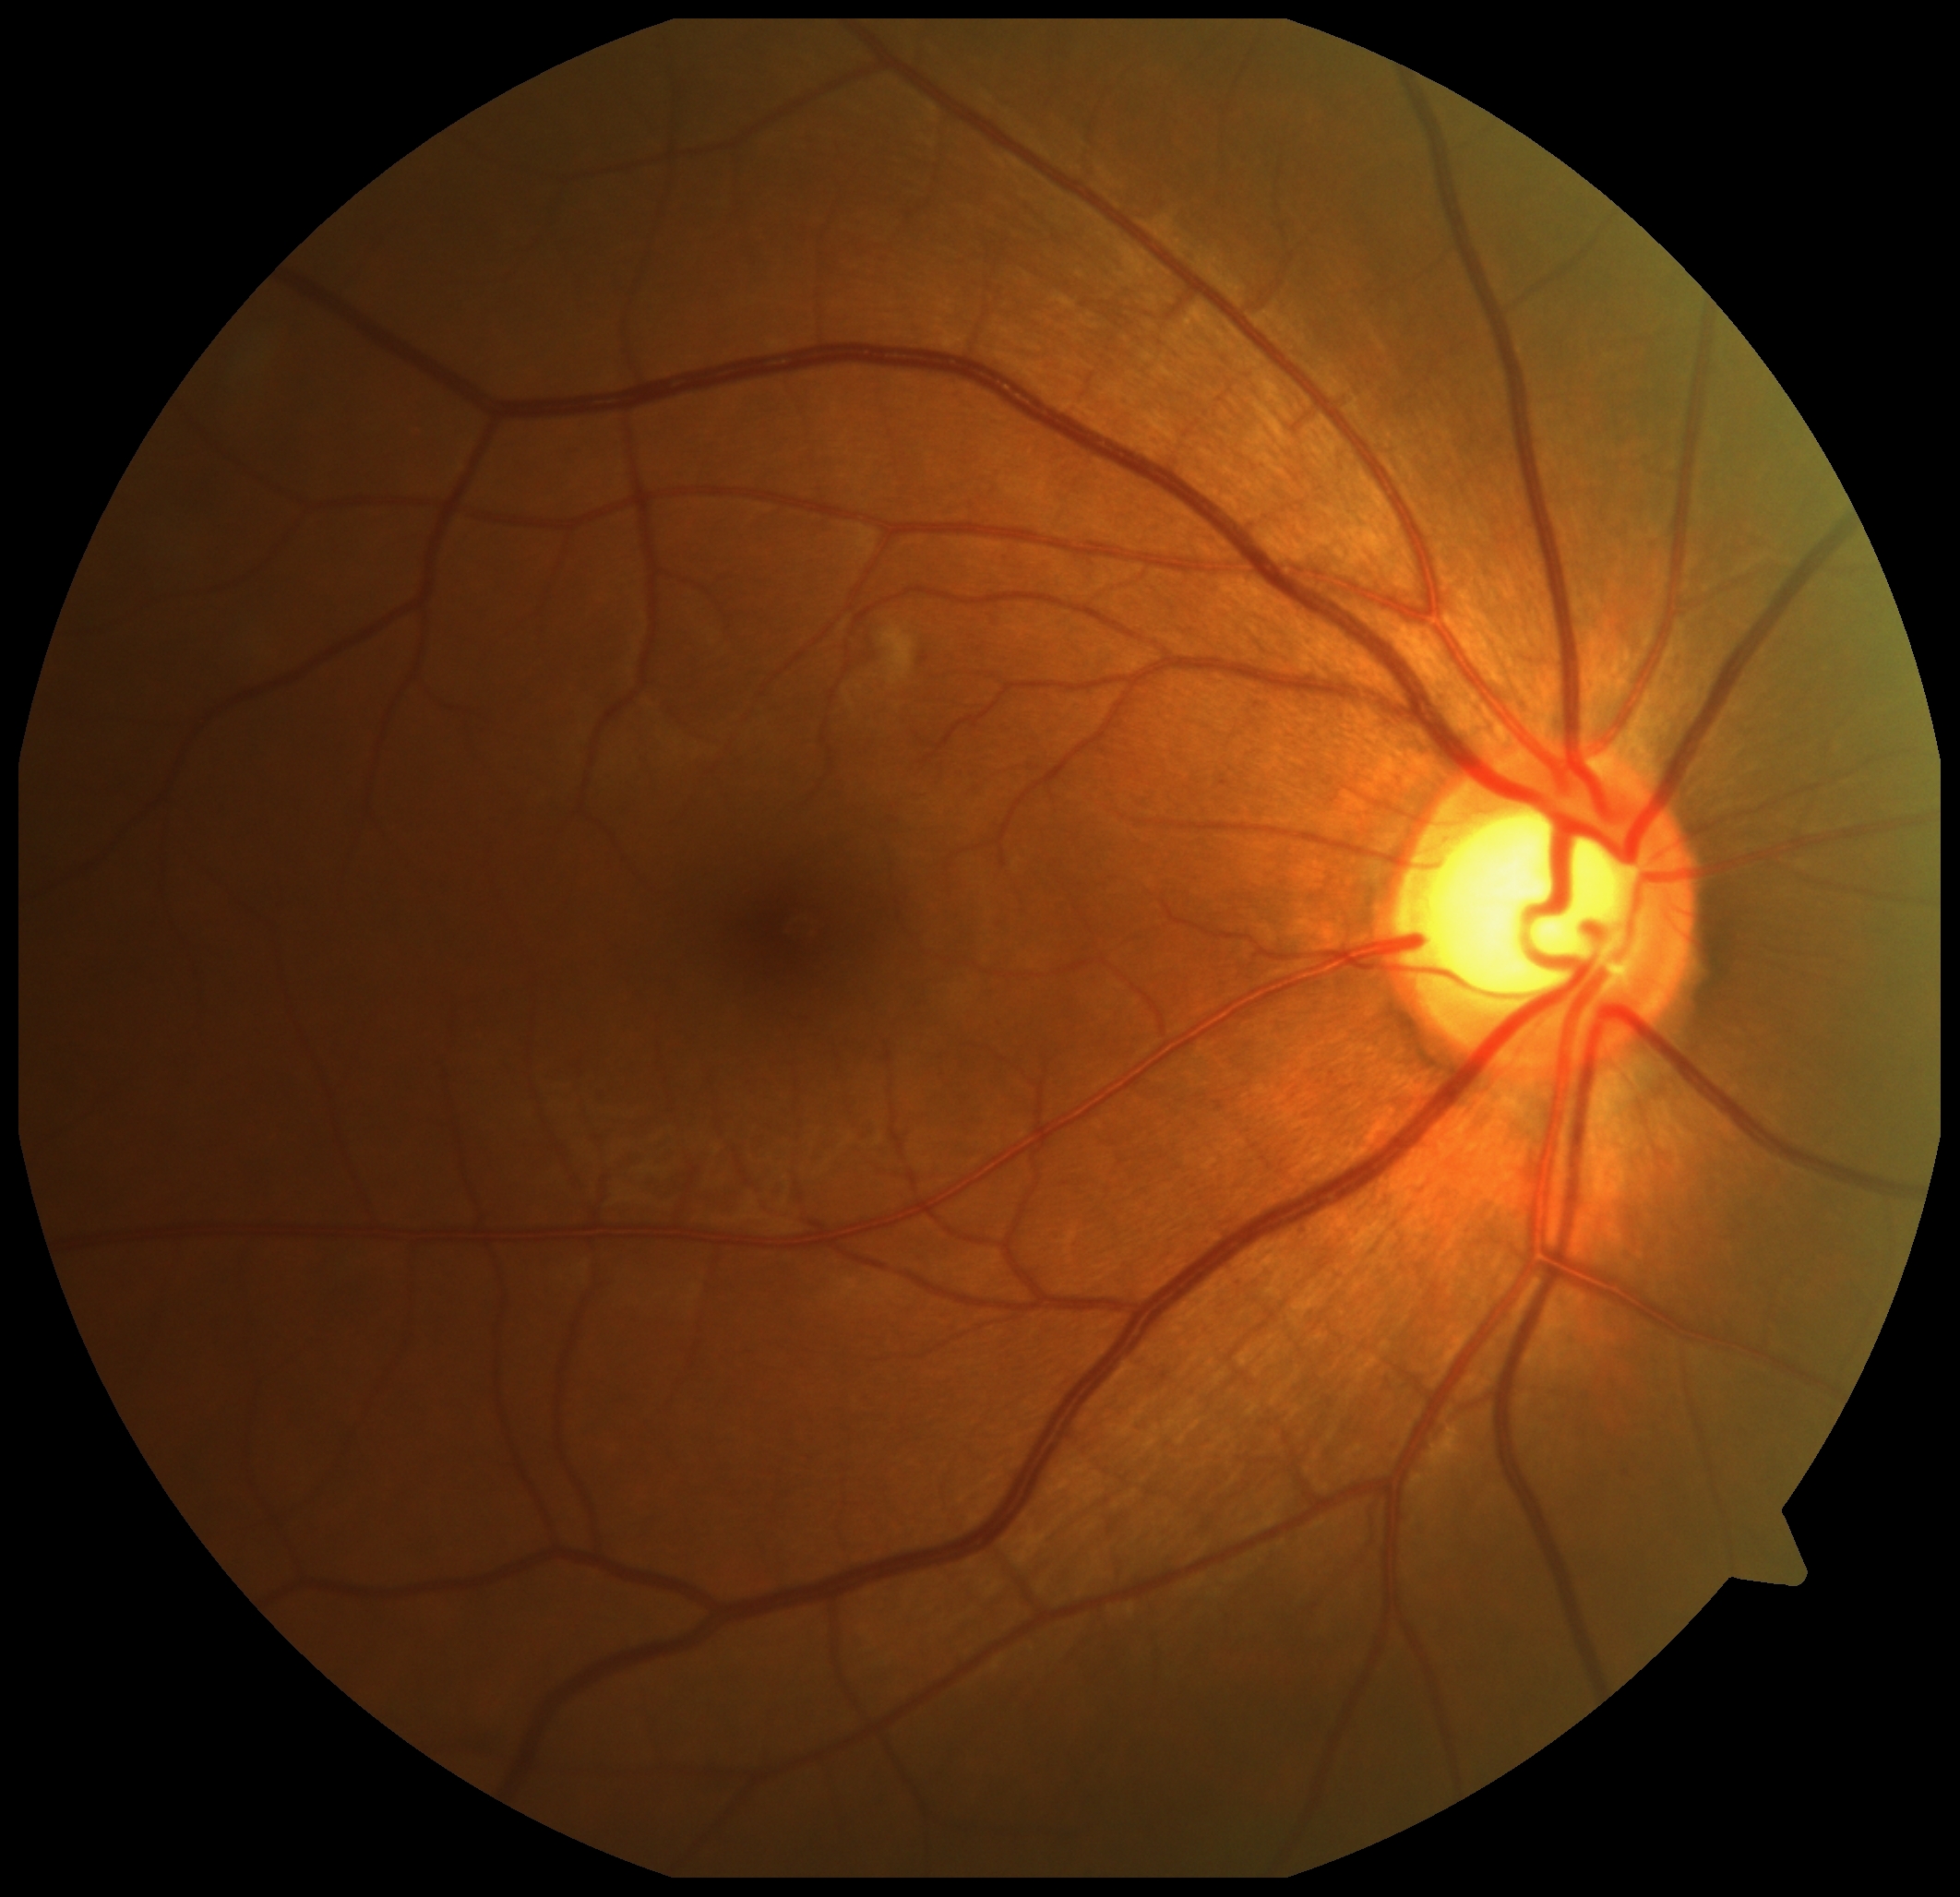
retinopathy grade=2 (moderate NPDR); DR class=non-proliferative diabetic retinopathy.